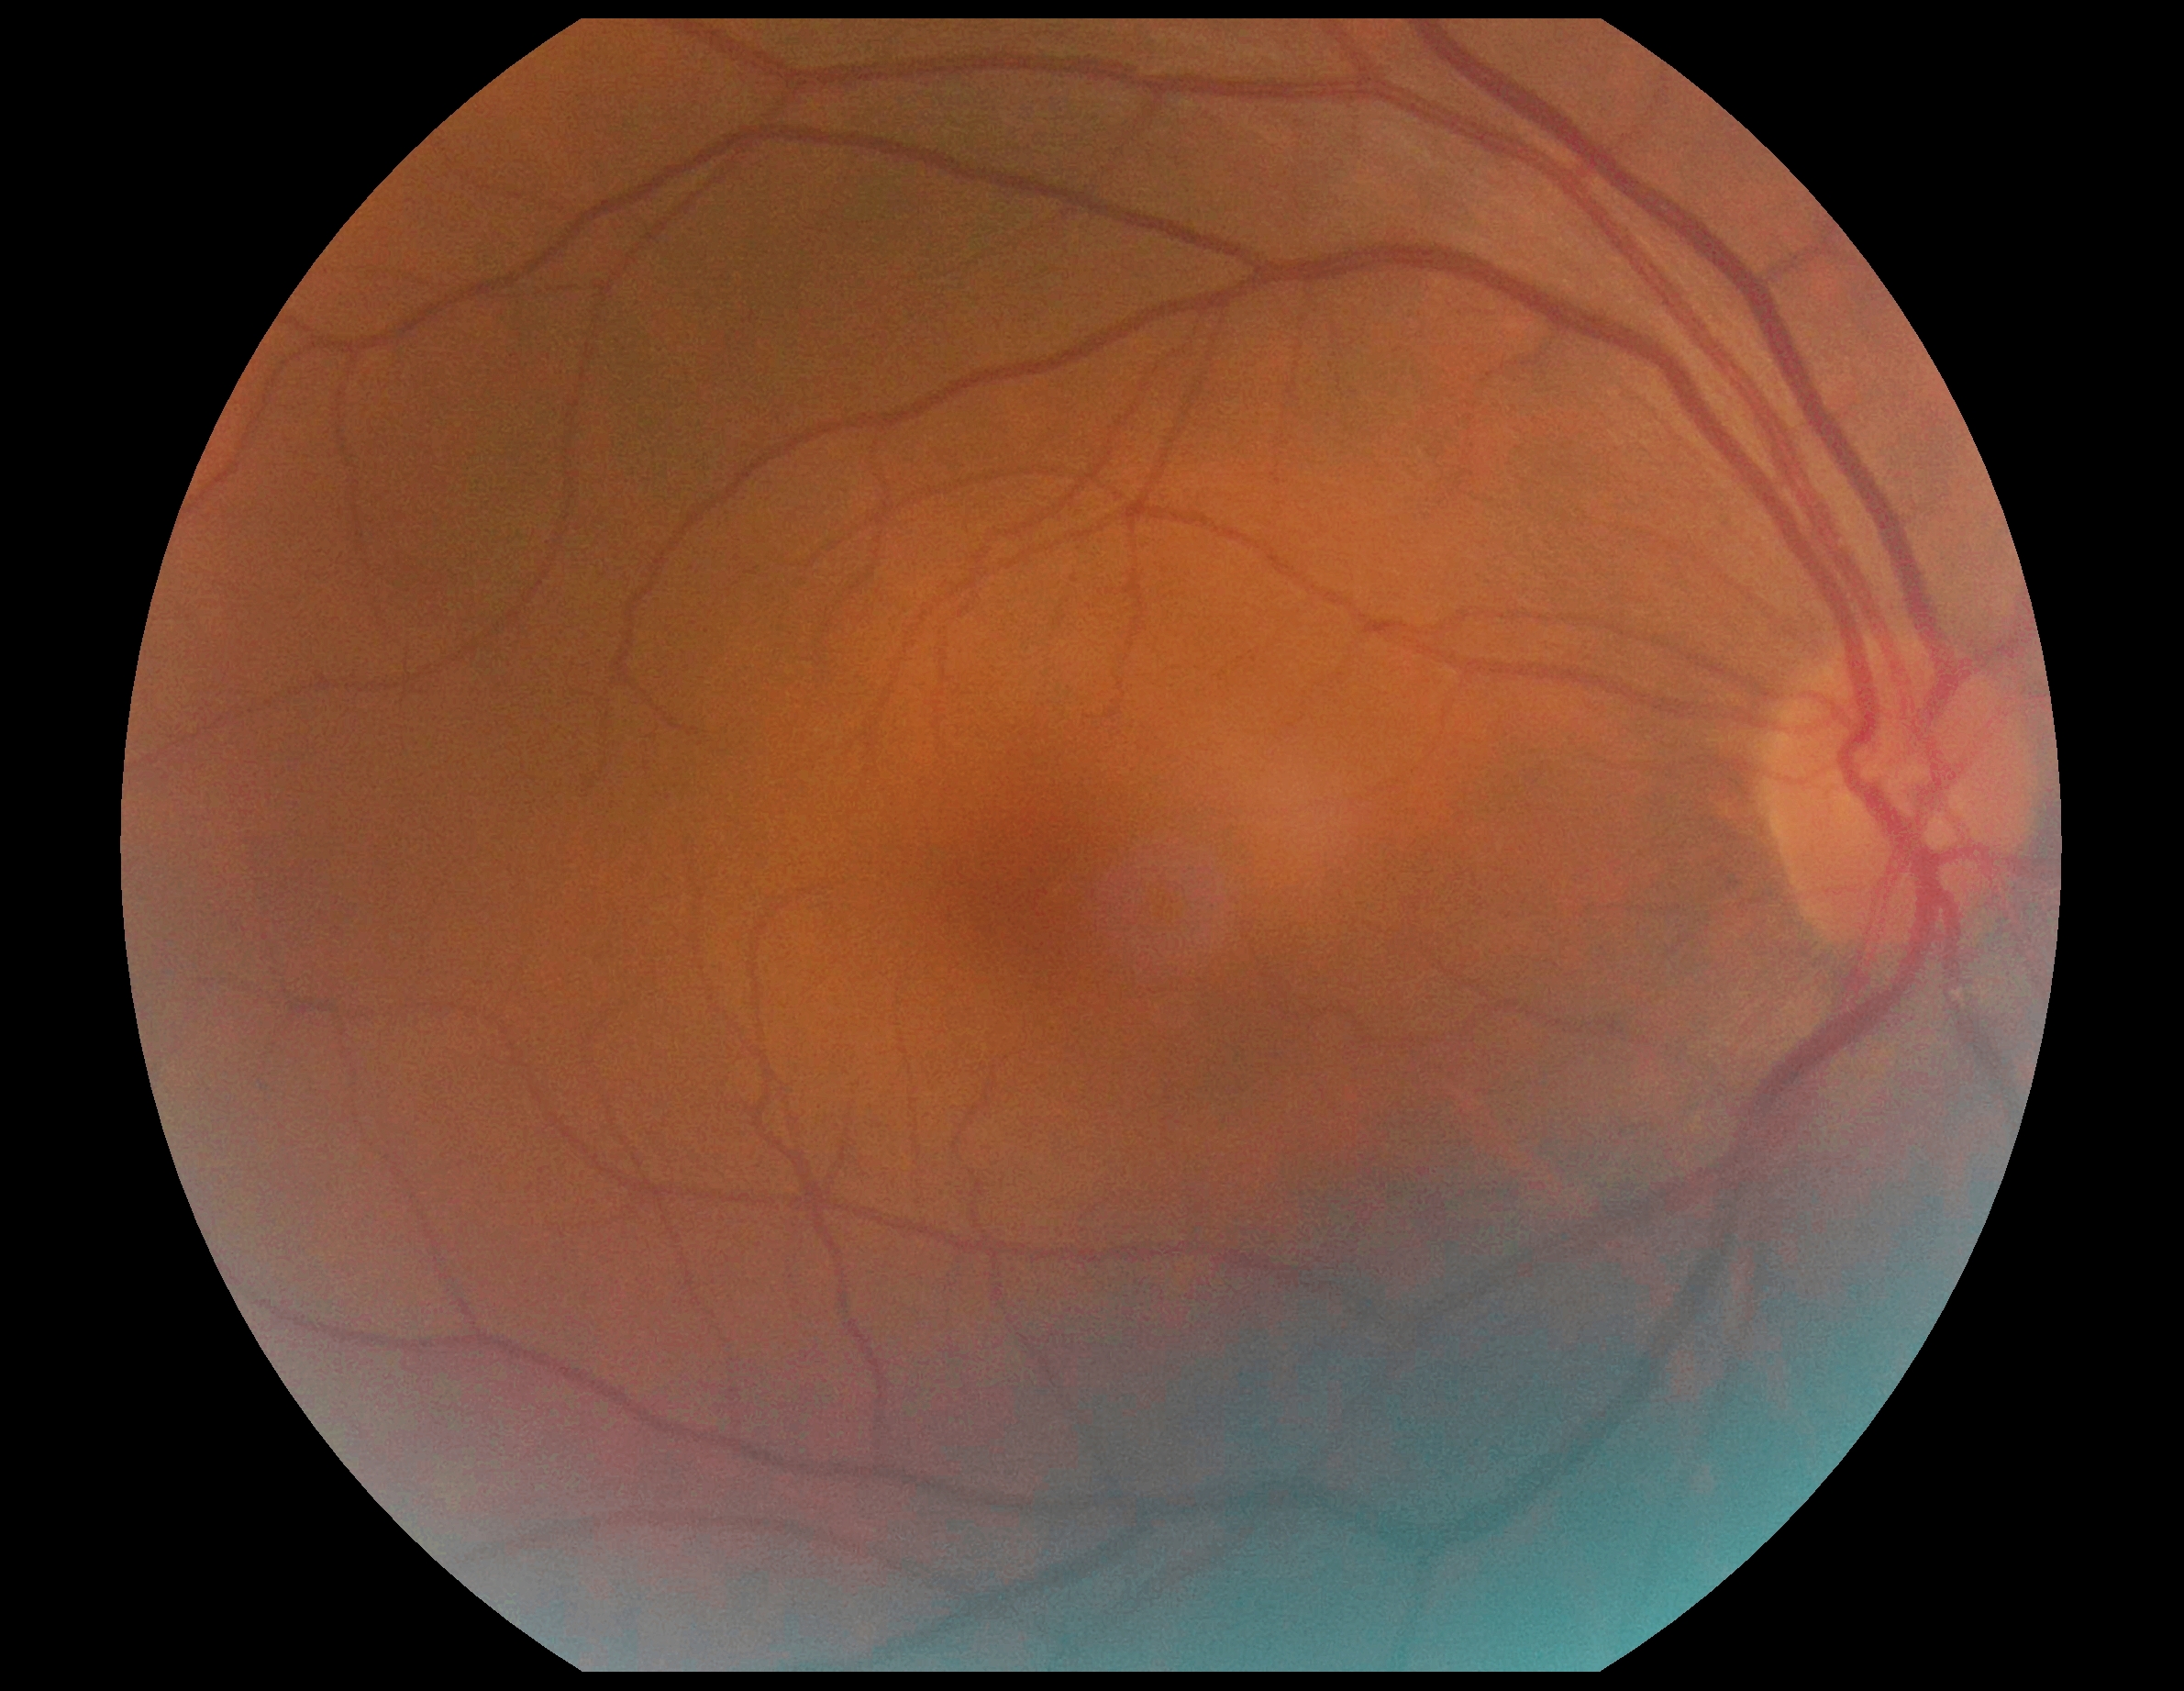 Diabetic retinopathy severity: grade 0.